Infant wide-field fundus photograph
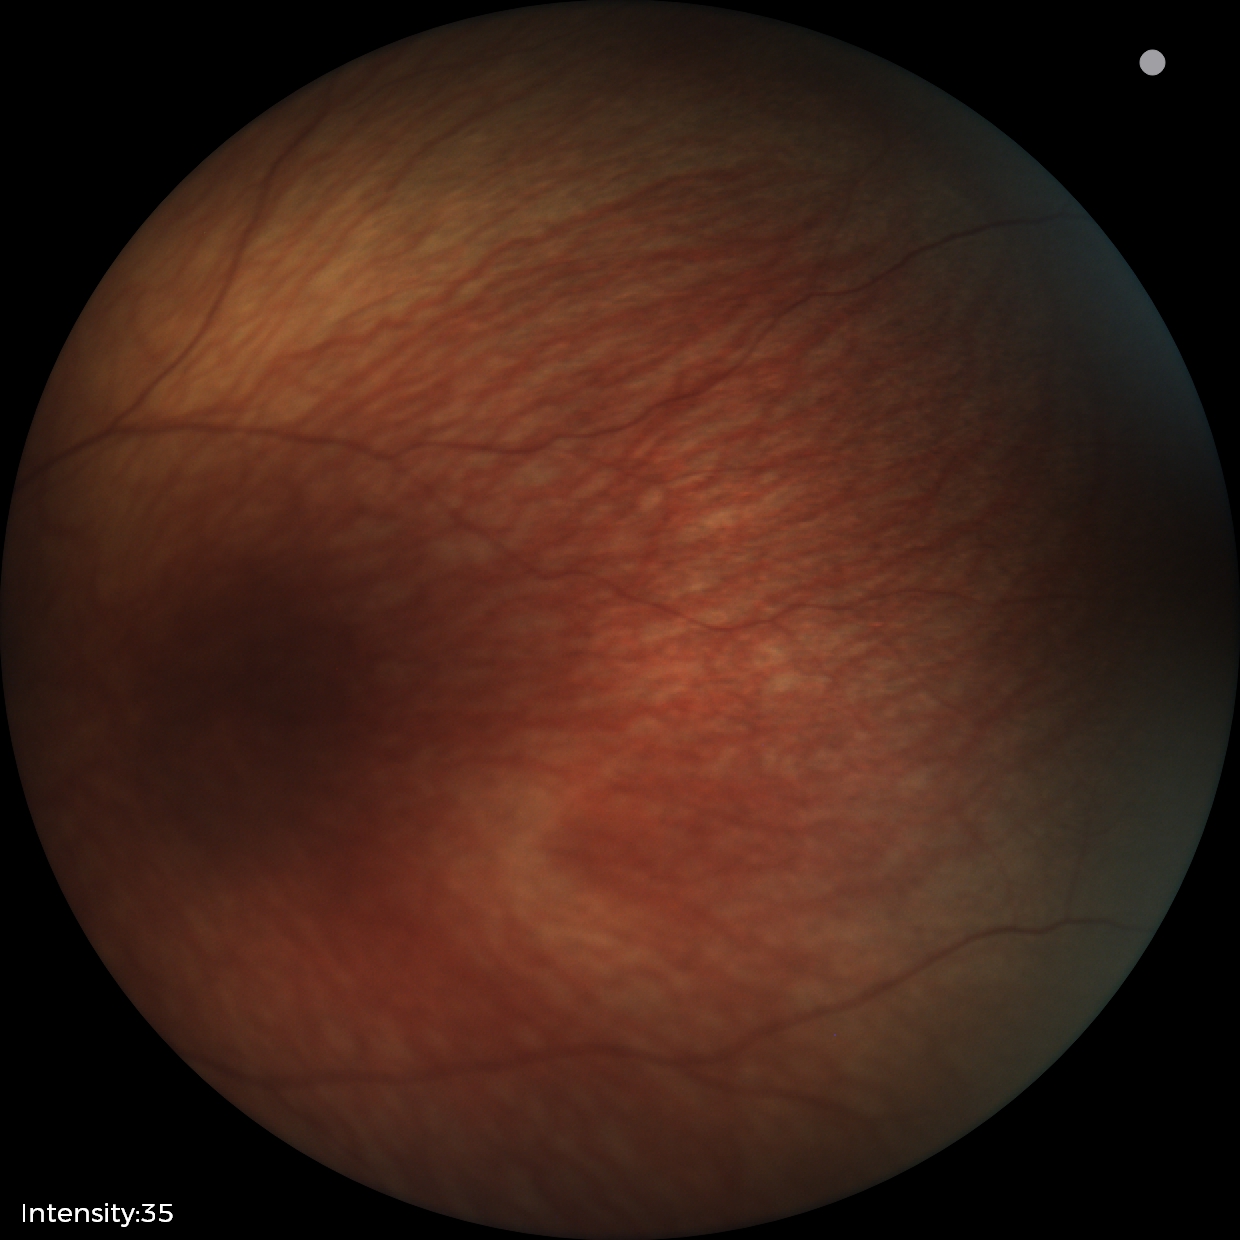

Screening examination with no abnormal retinal findings.